Infant wide-field retinal image · 1240x1240px · acquired on the Phoenix ICON: 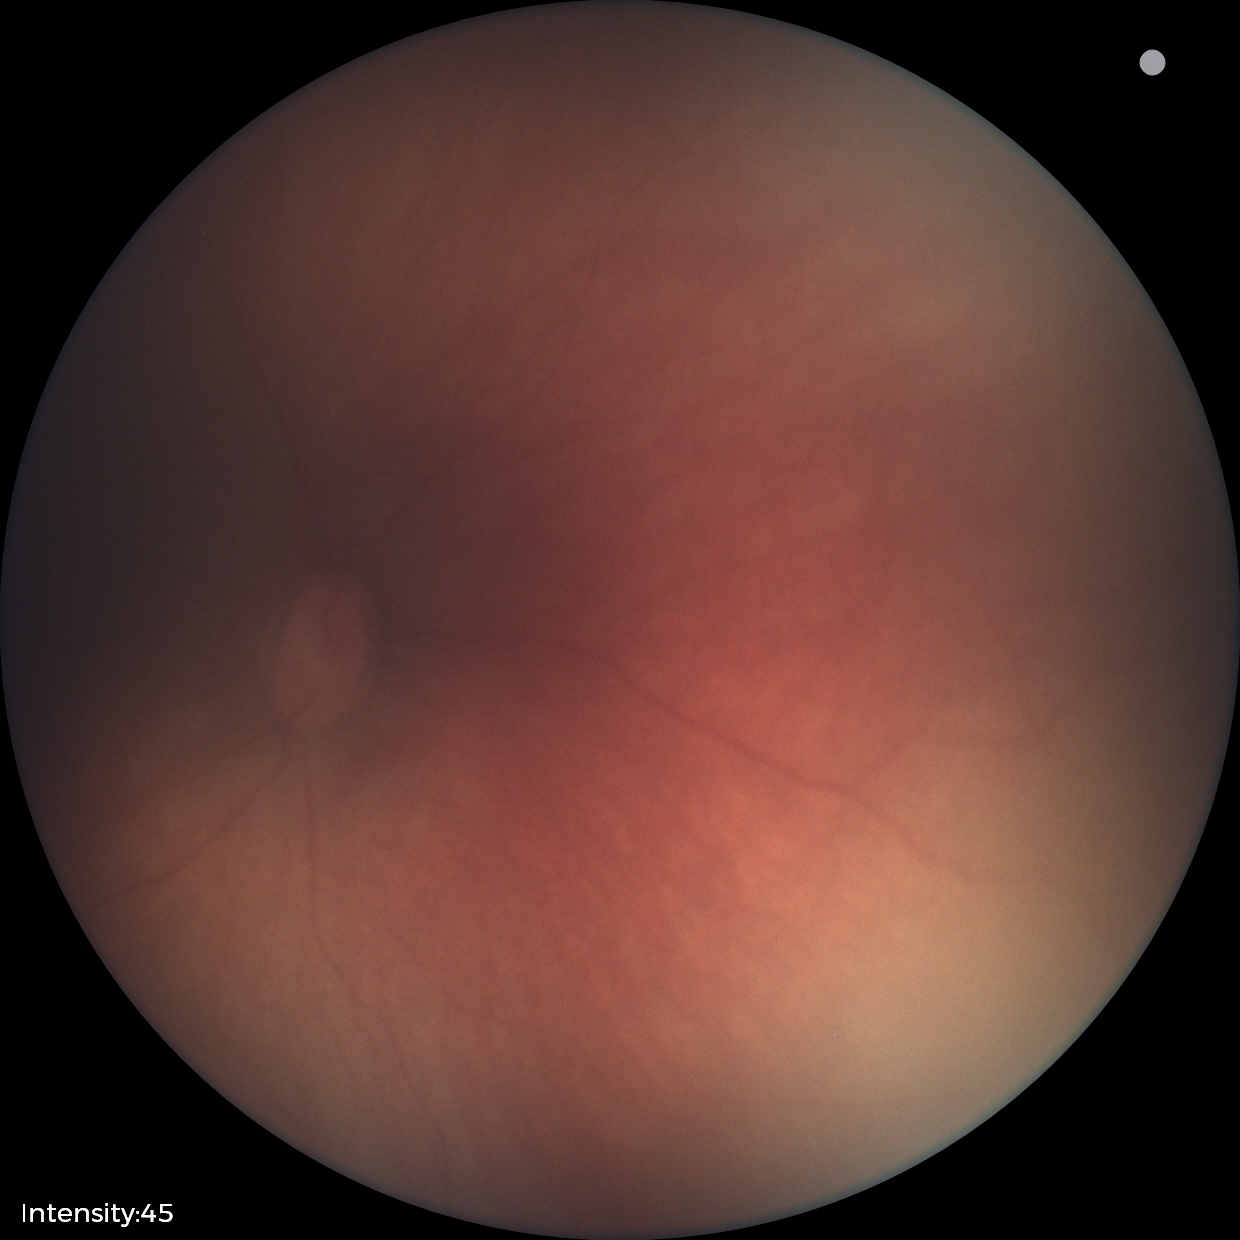 No retinal pathology identified on screening.